Infant wide-field retinal image — 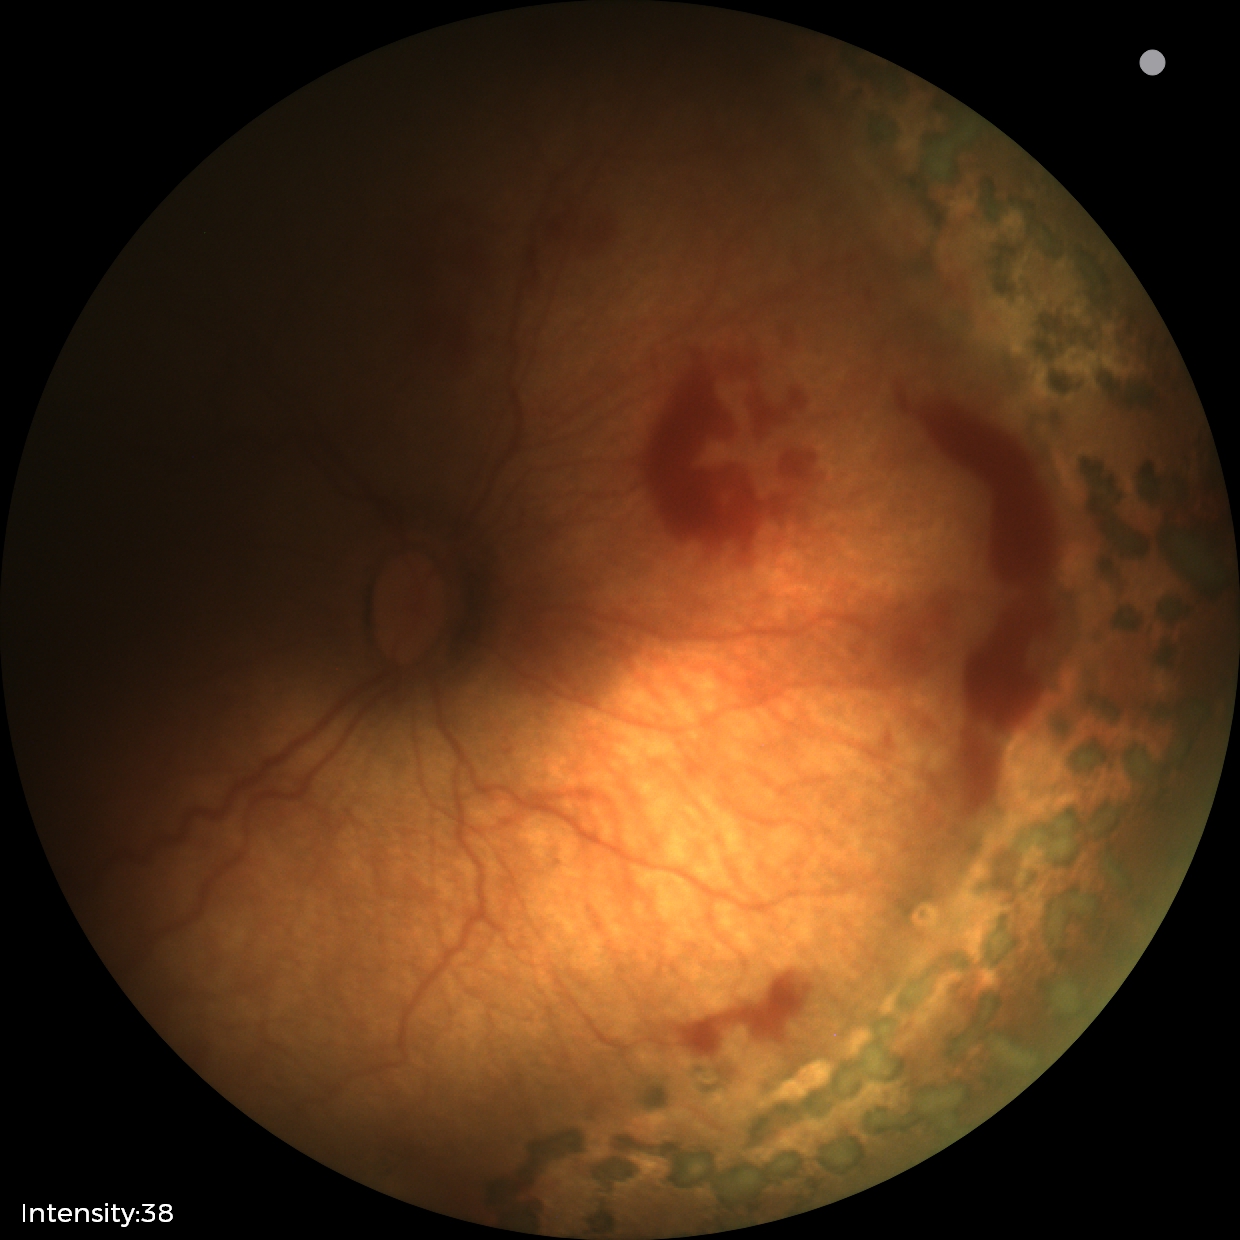

Without plus disease.
Examination diagnosed as status post ROP.